Captured on a Remidio Fundus on Phone (FOP) camera
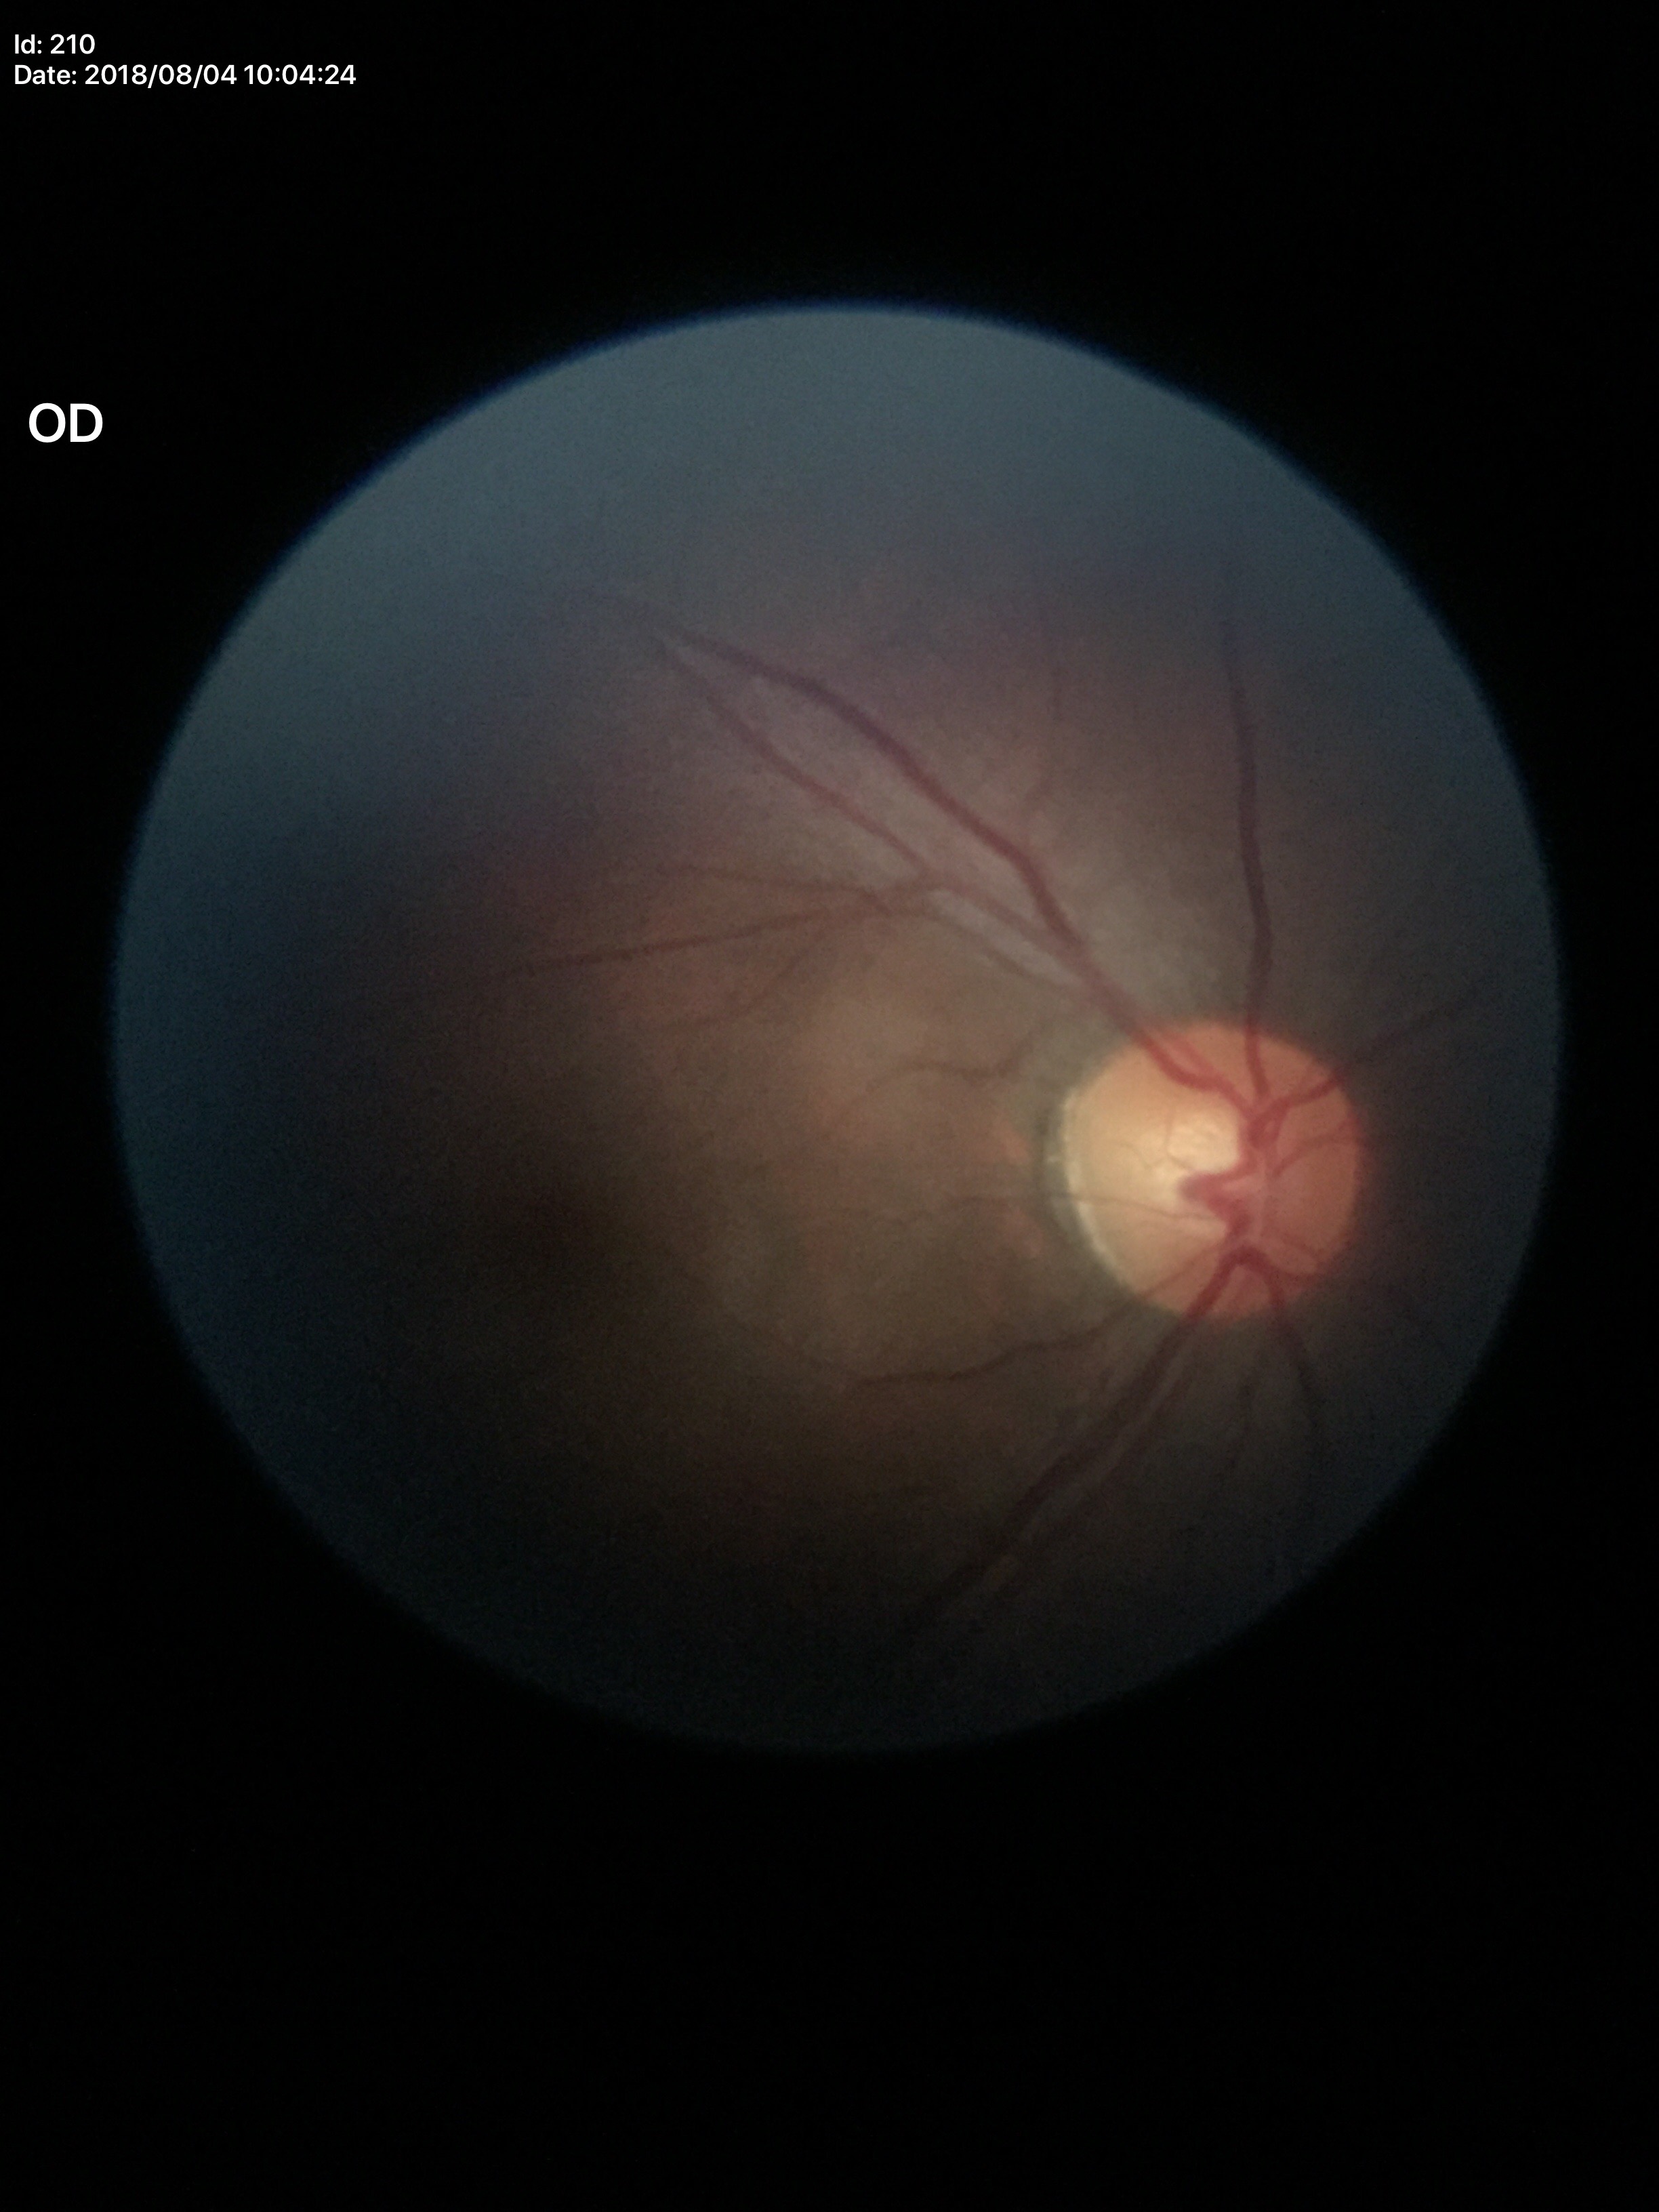

Glaucoma assessment: negative. Vertical C/D ratio: 0.55. Horizontal cup-disc ratio: 0.56.